640x480 · infant wide-field retinal image
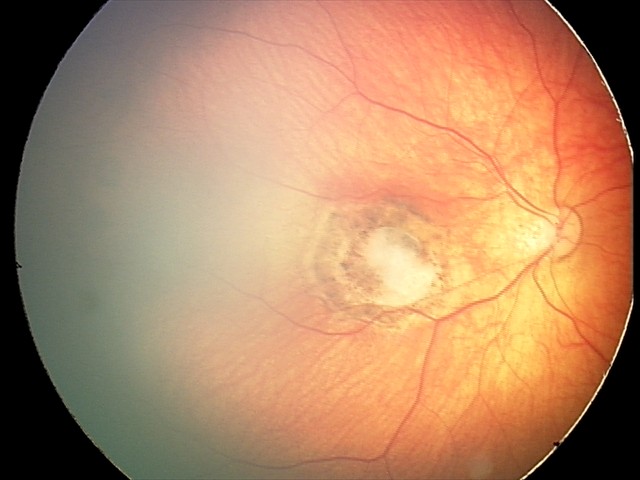
Assessment: toxoplasmosis chorioretinitis.